1440x1080px; infant wide-field retinal image — 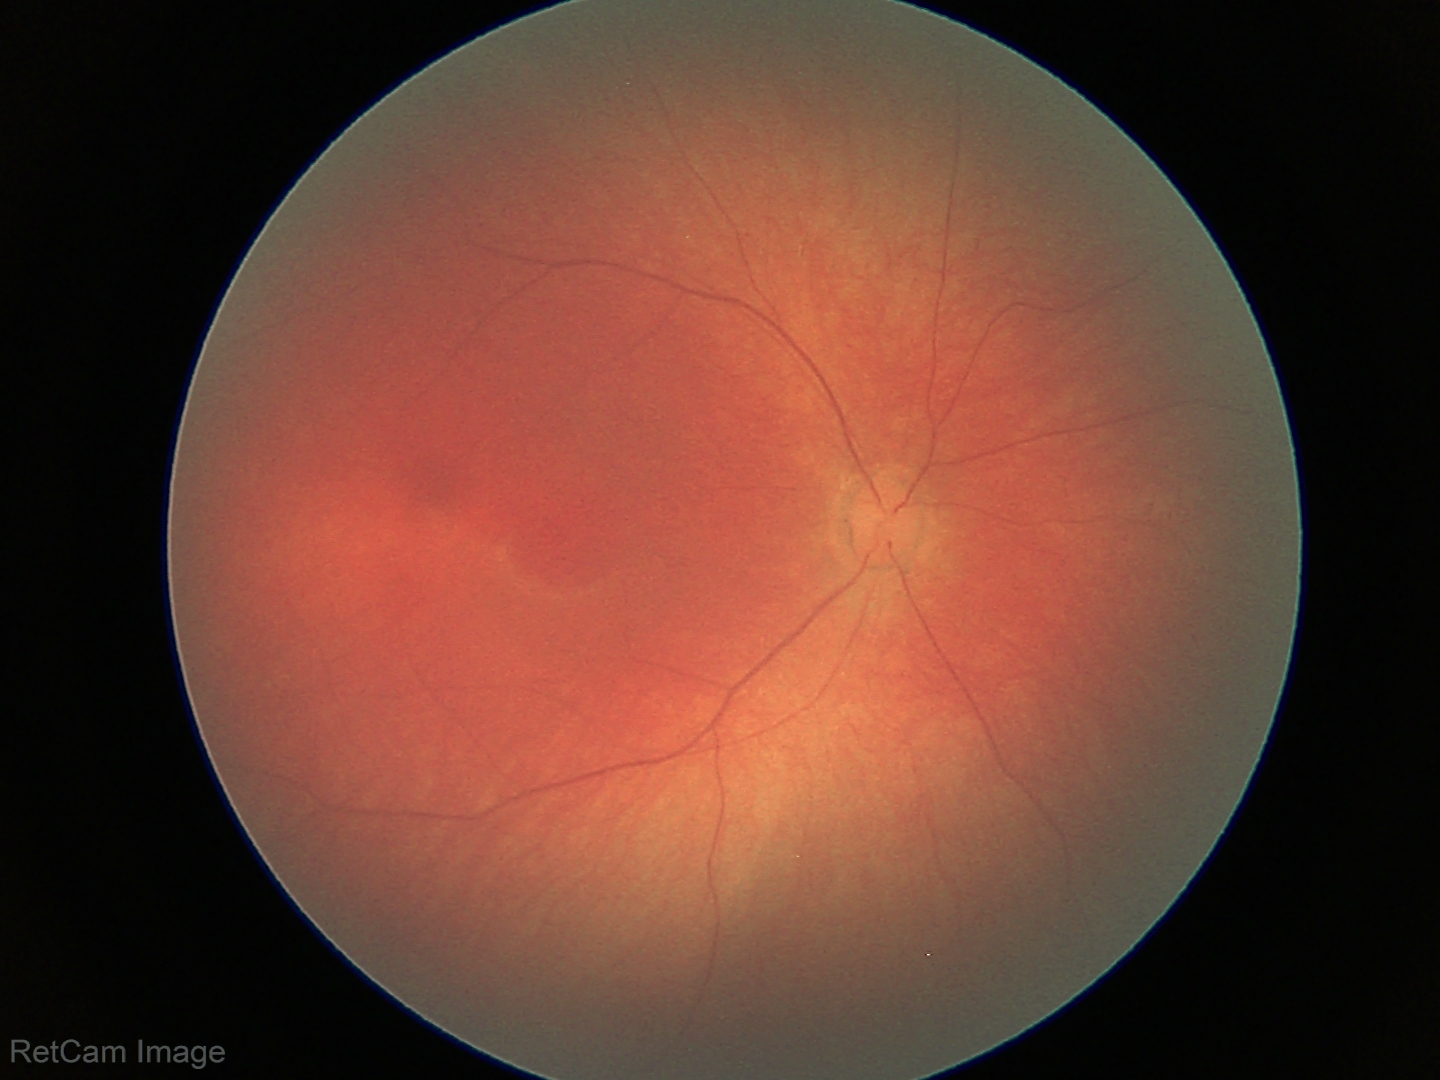

Examination with physiological retinal findings.